Color fundus photograph; 45-degree field of view:
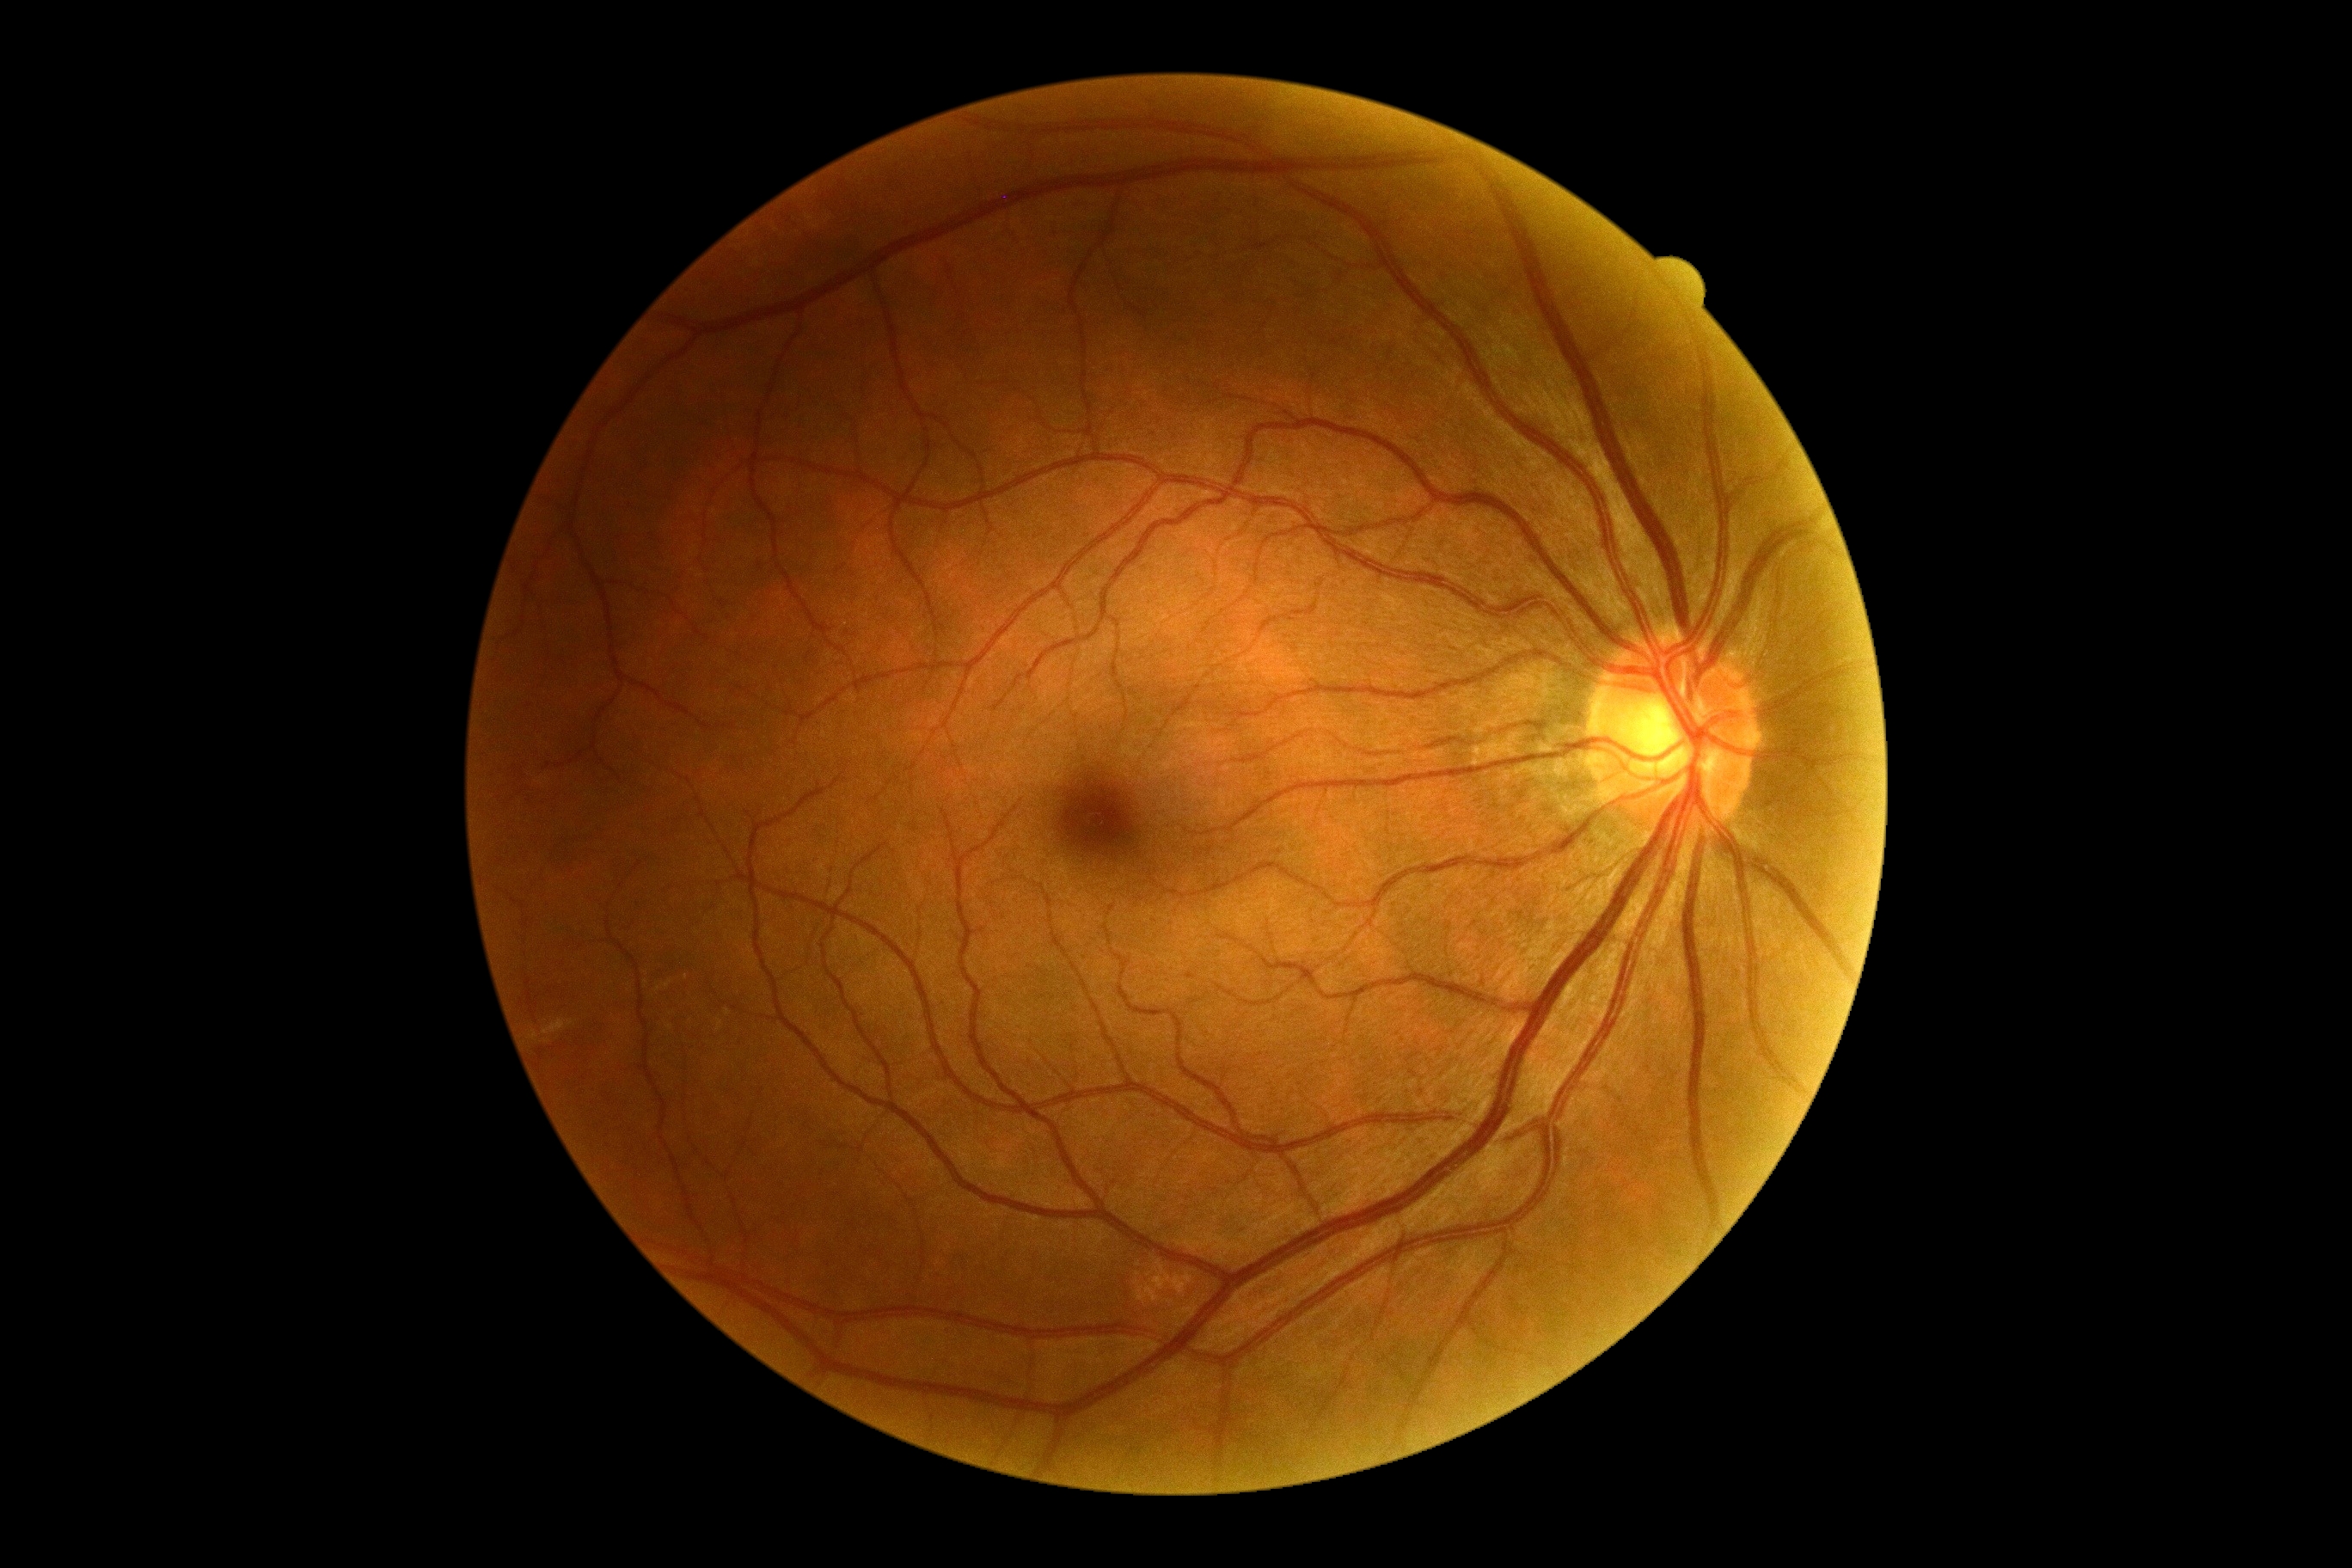 No DR findings. Diabetic retinopathy: 0/4.